CFP · FOV: 45 degrees: 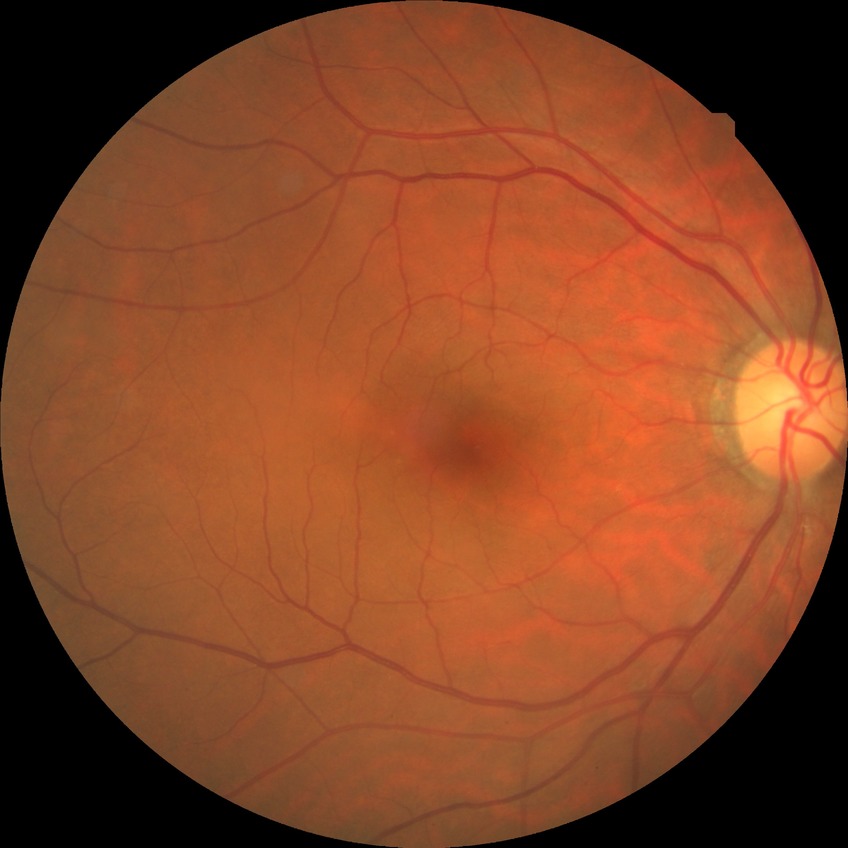
Modified Davis grading: no diabetic retinopathy.